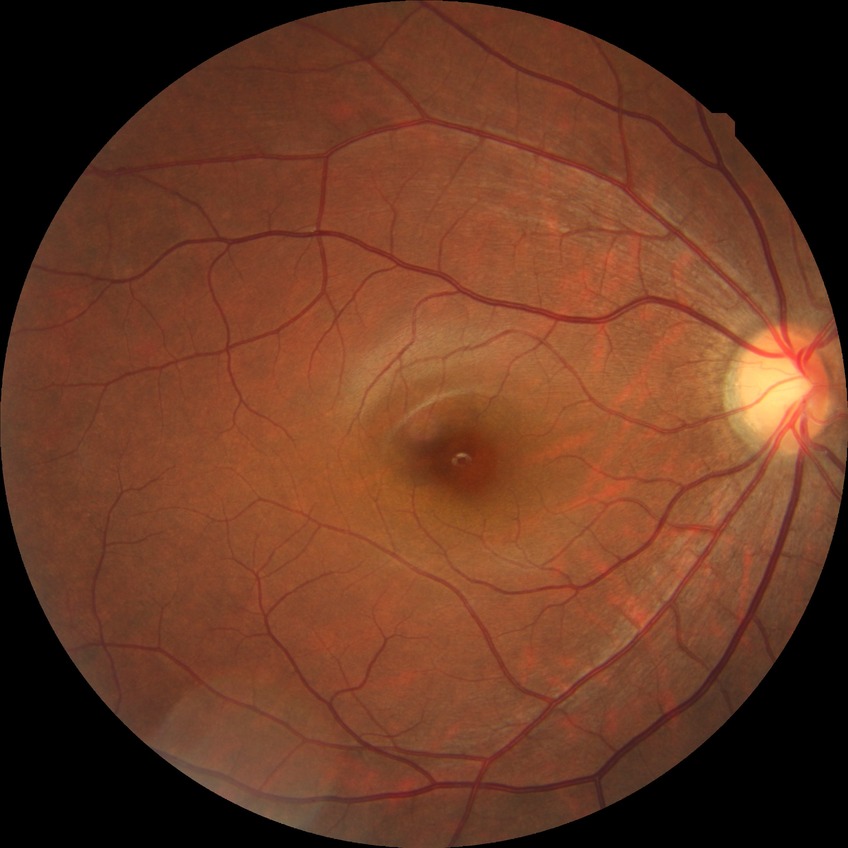

Diabetic retinopathy severity is no diabetic retinopathy.